Ultra-widefield fundus mosaic
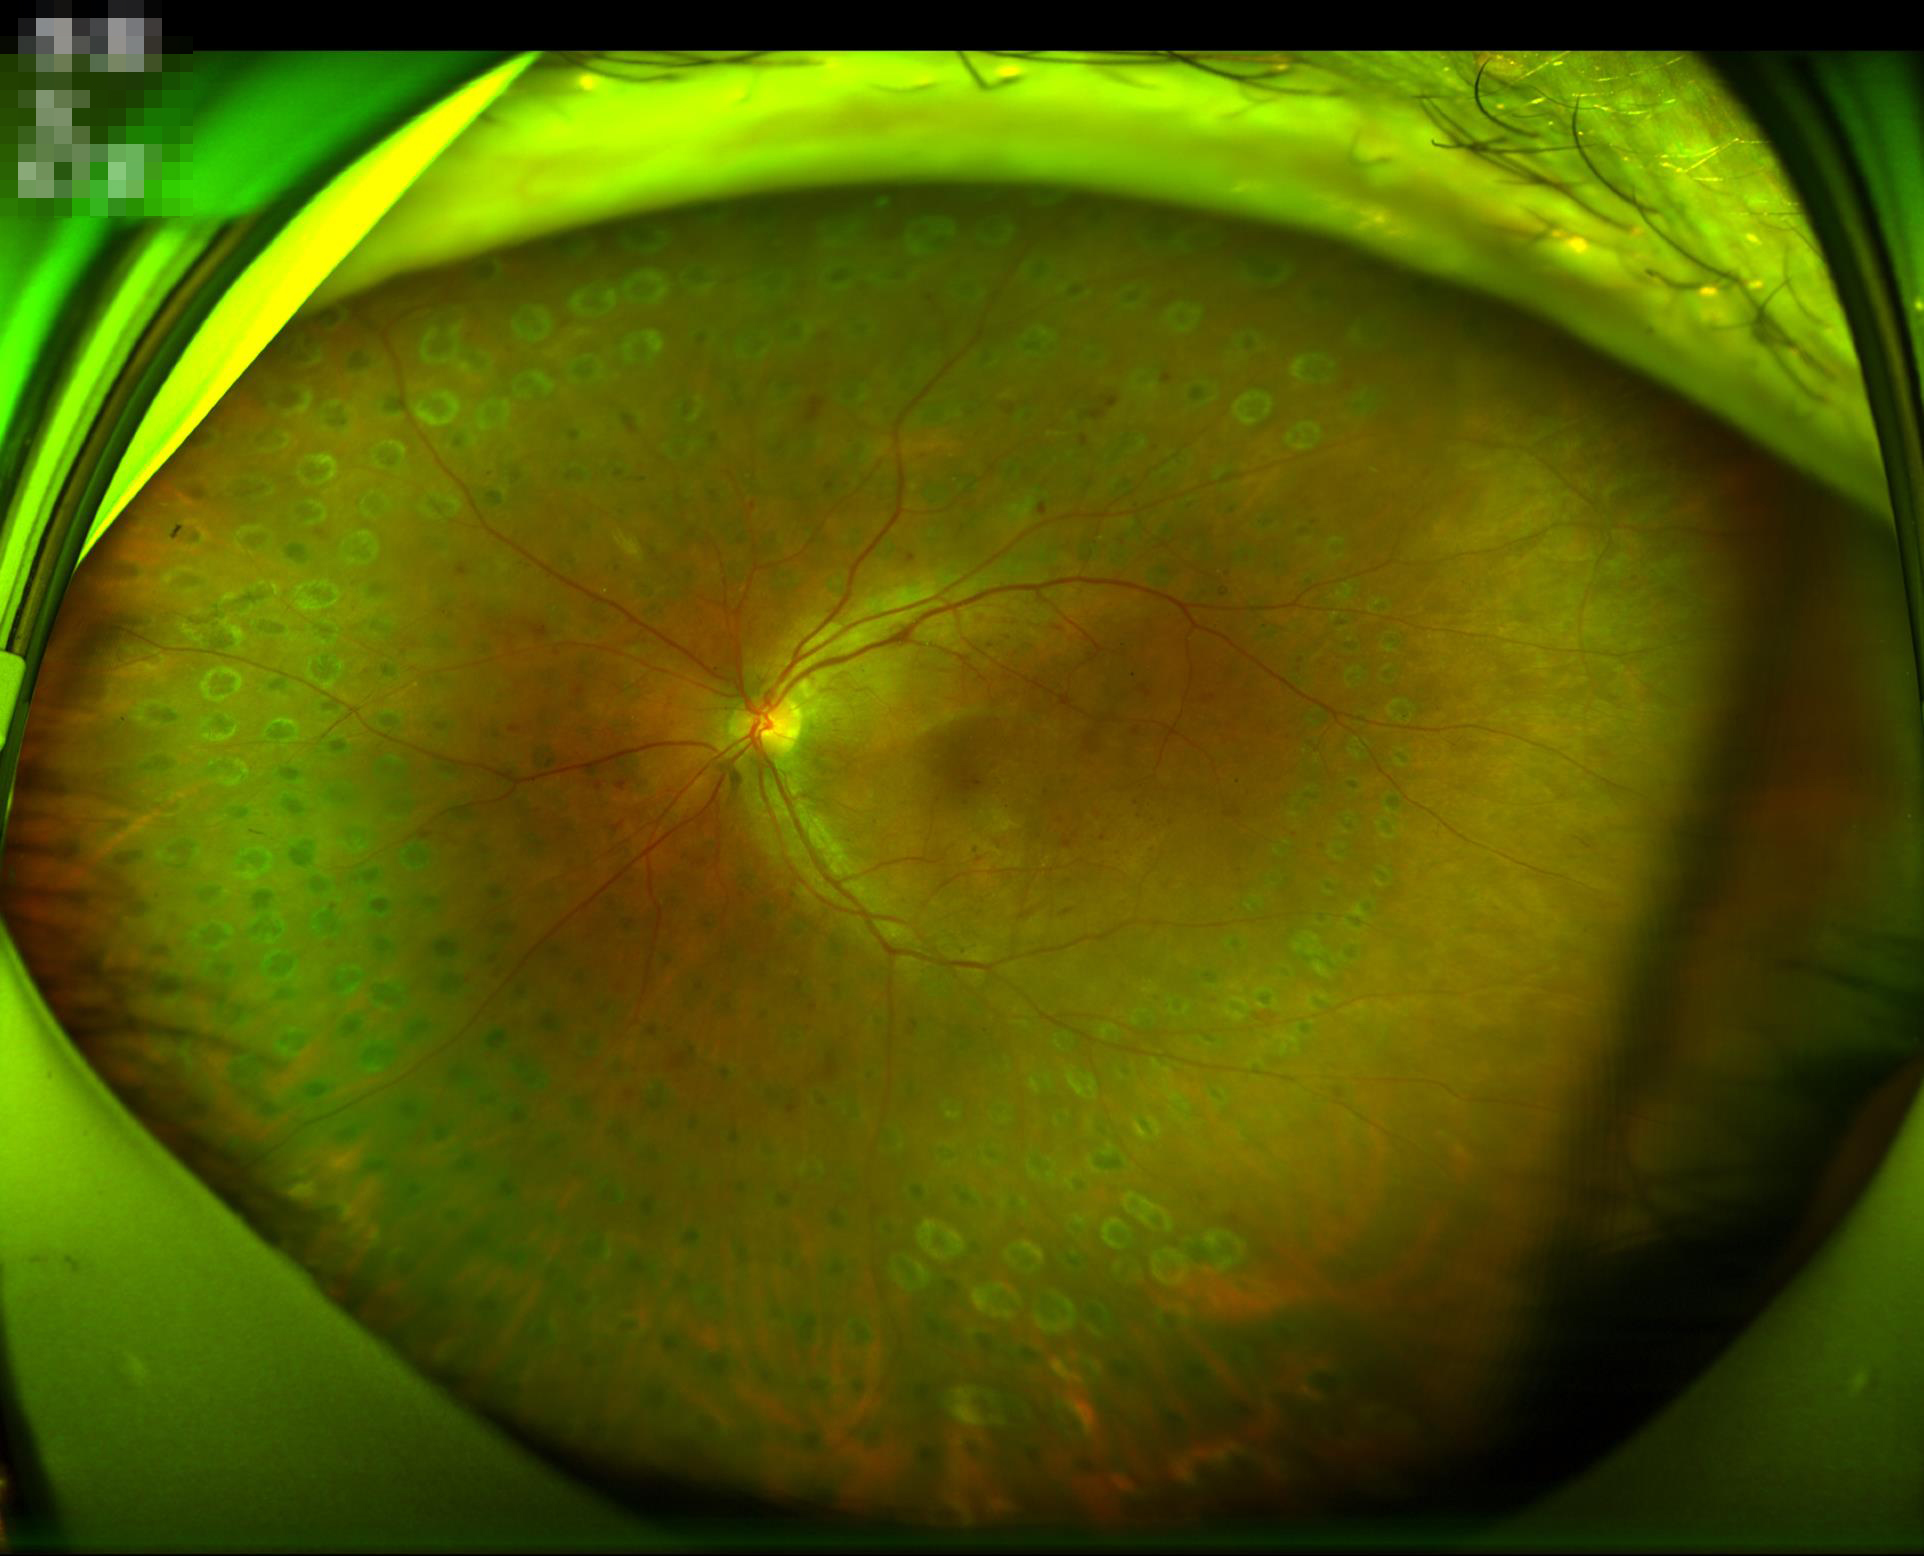
Quality assessment: contrast: adequate; overall: satisfactory; illumination/color: good.